2212 by 1659 pixels · 45-degree field of view · color fundus photograph — 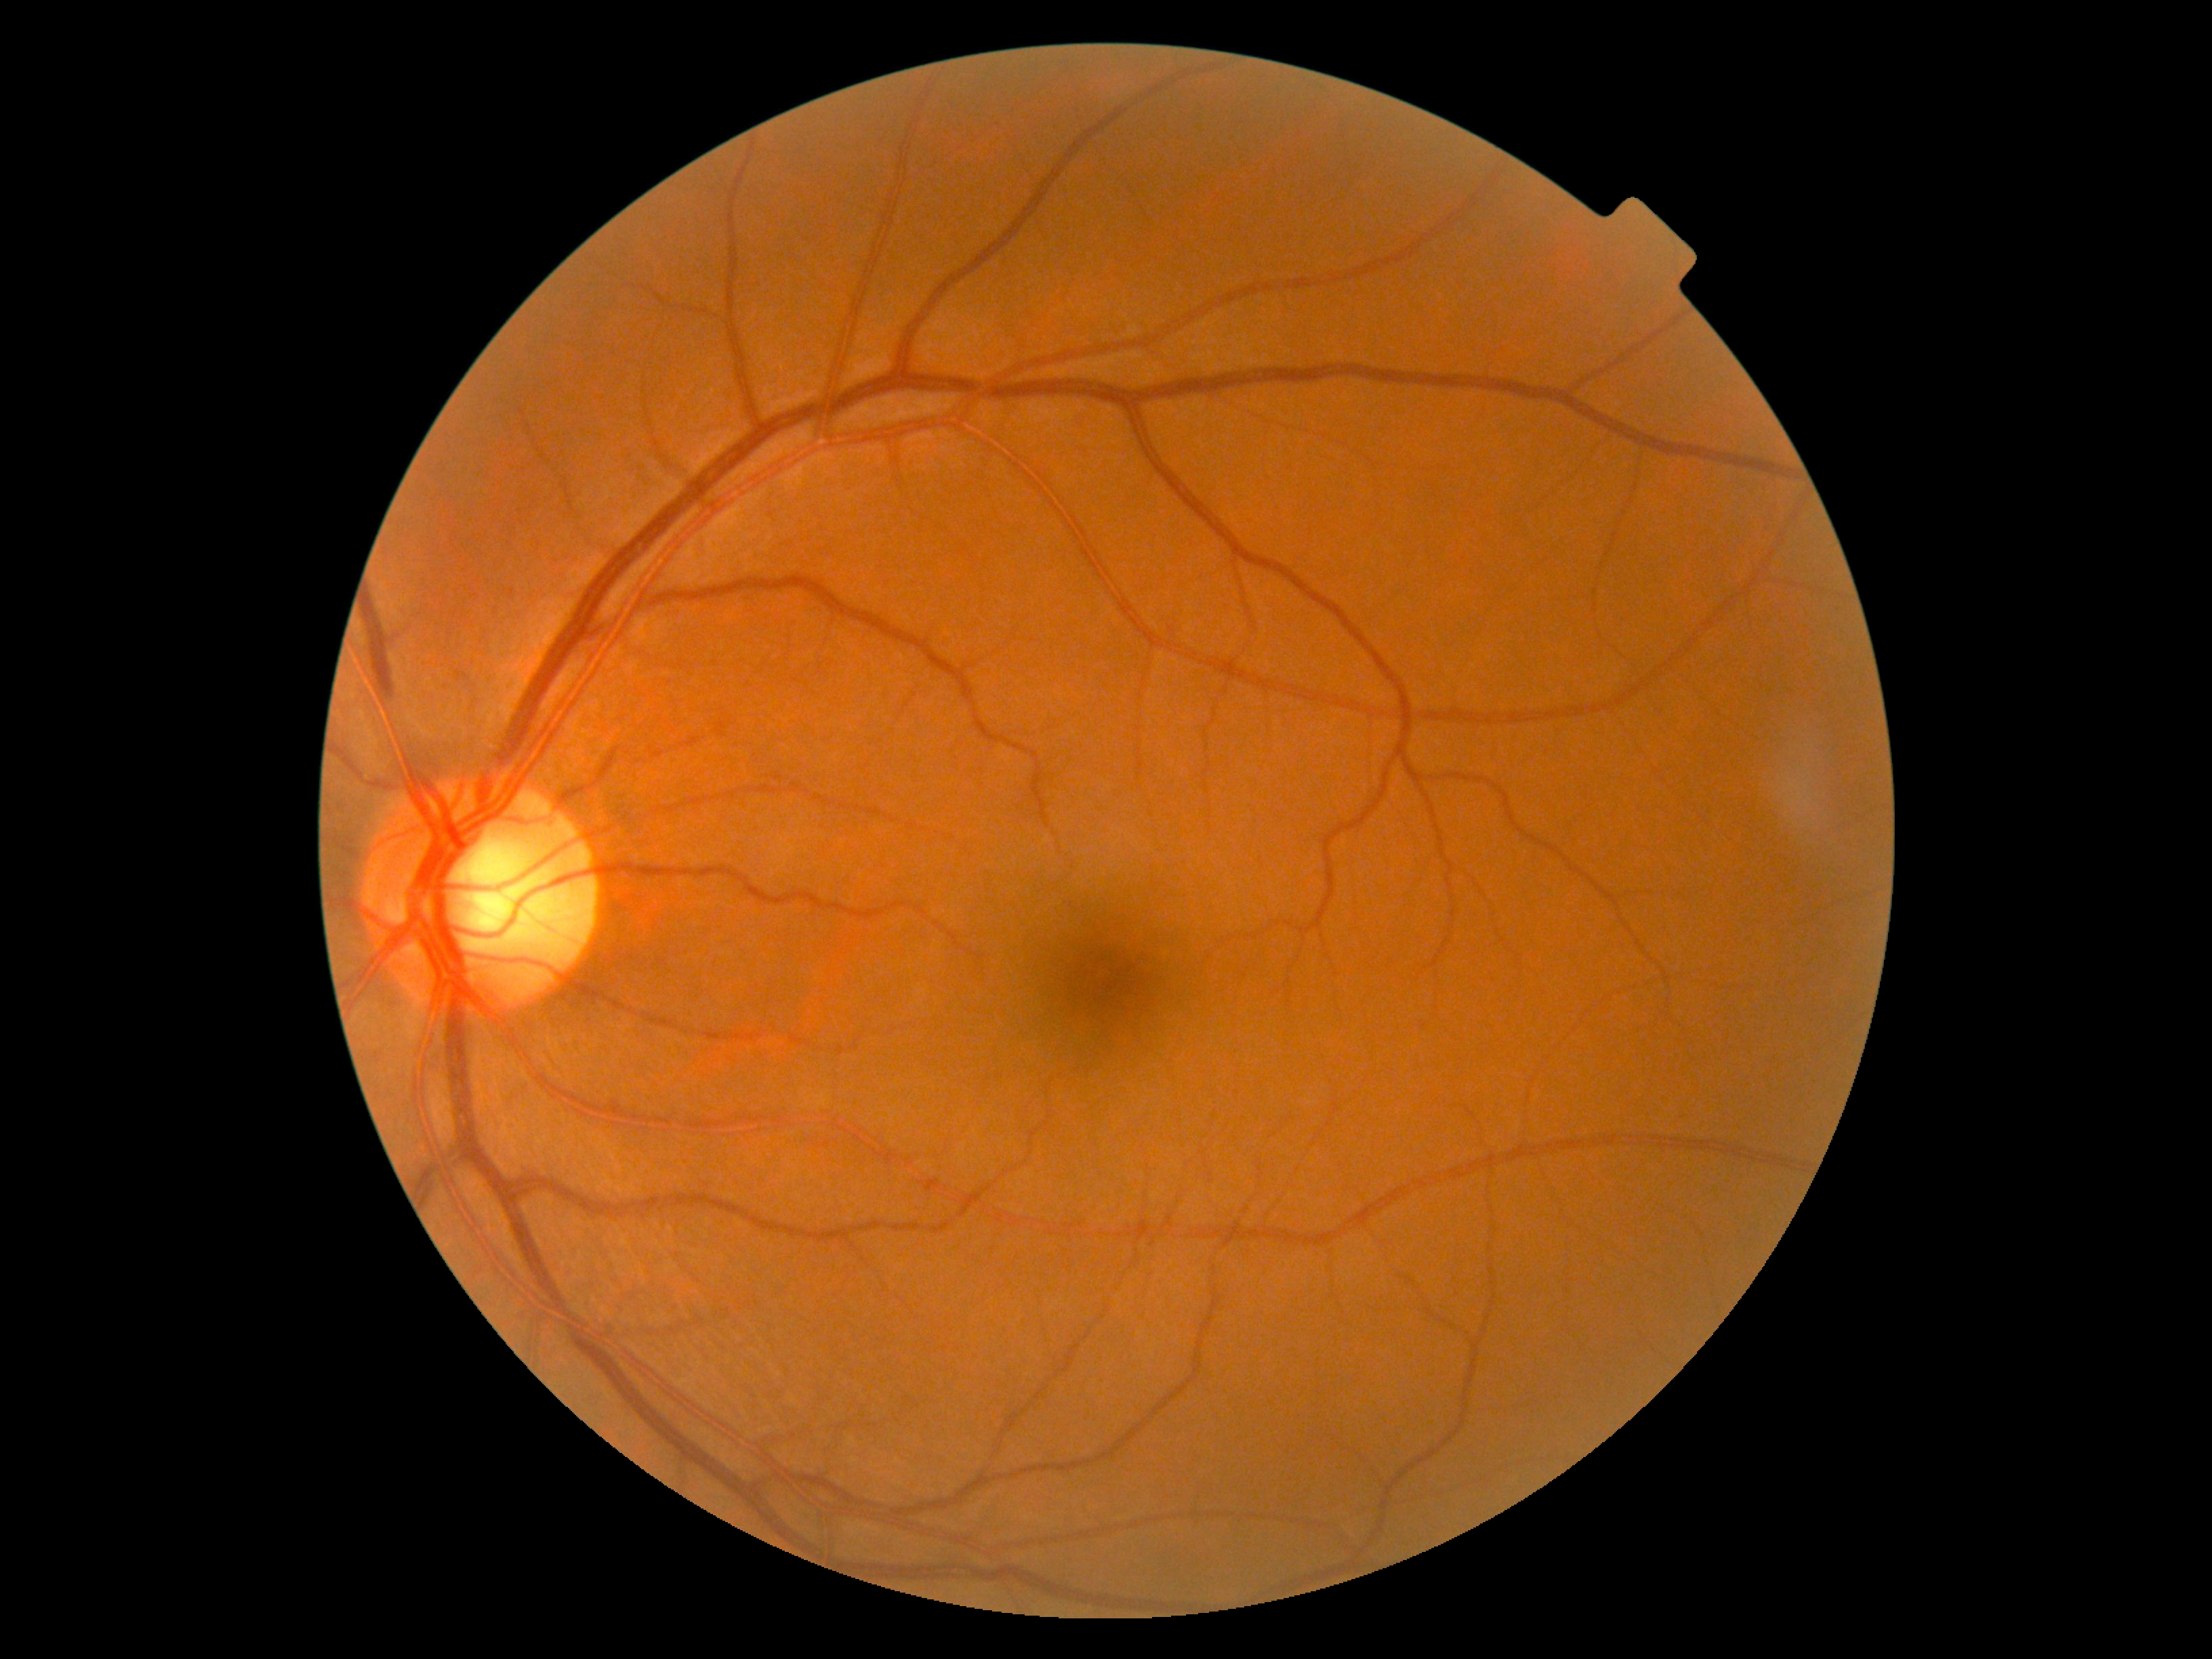

DR severity=0 — no visible signs of diabetic retinopathy.